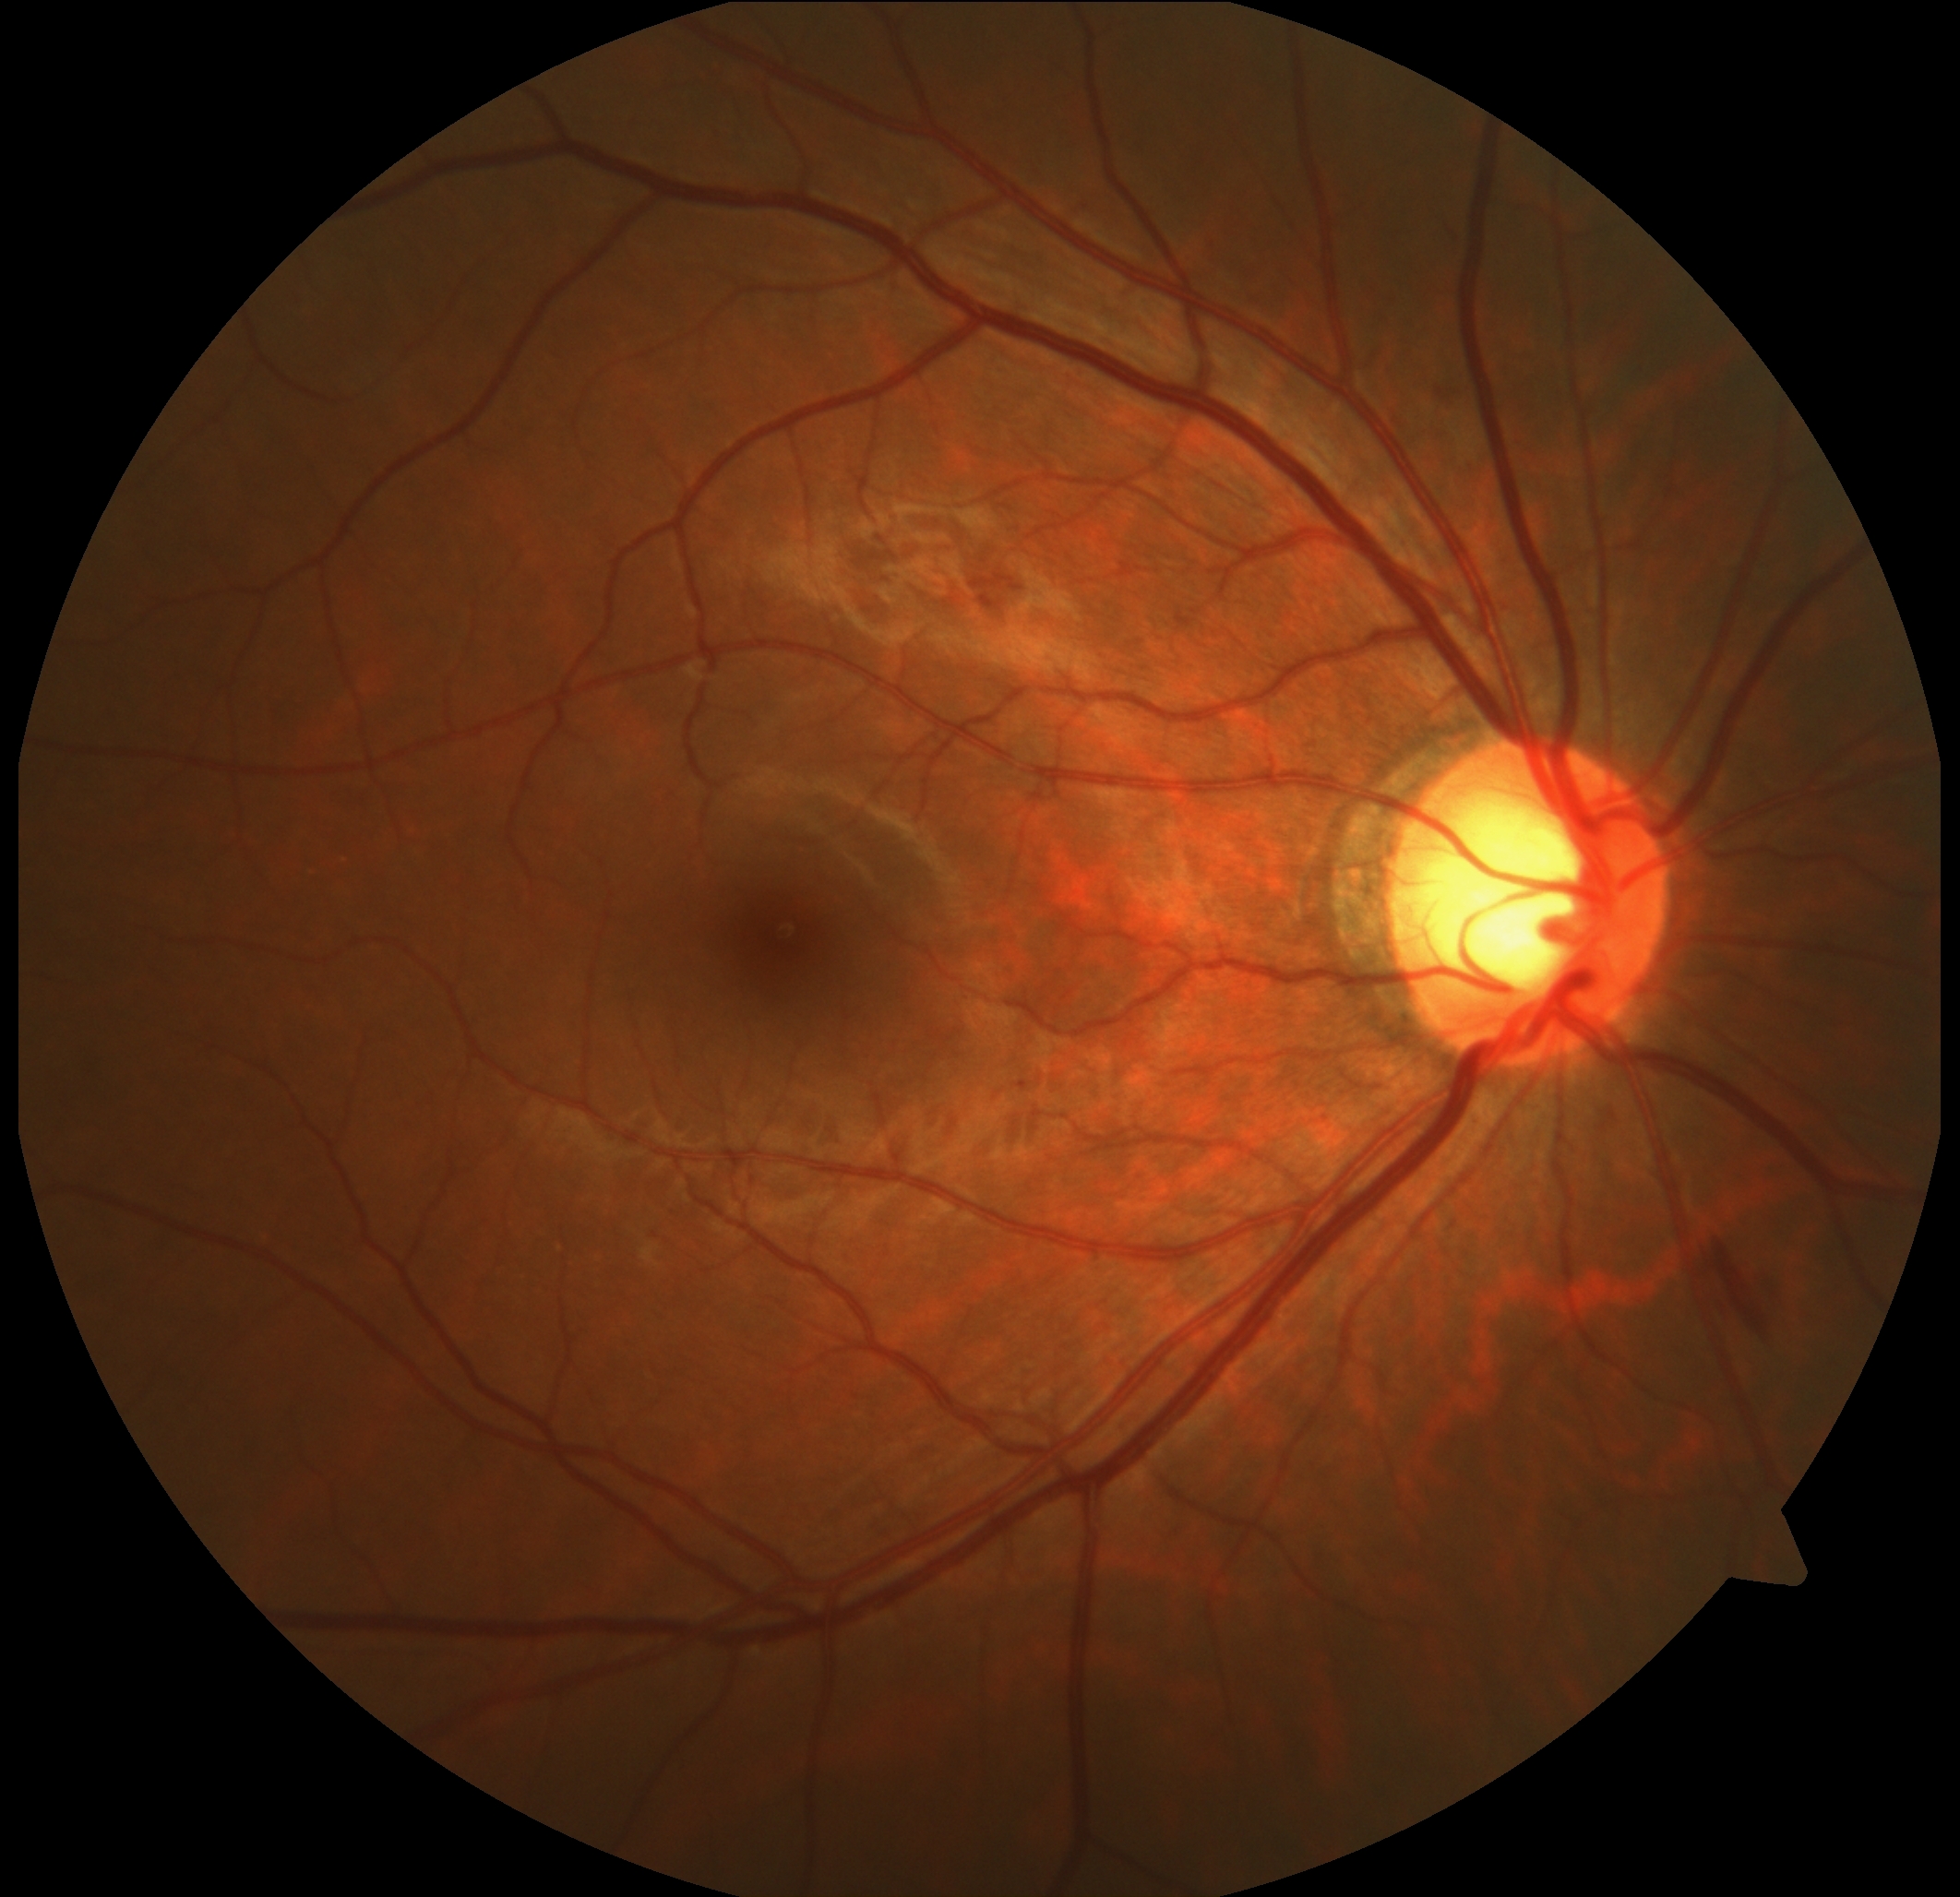 Diabetic retinopathy: moderate non-proliferative diabetic retinopathy (grade 2) — more than just microaneurysms but less than severe NPDR.
DR class: non-proliferative diabetic retinopathy.